Wide-field contact fundus photograph of an infant: 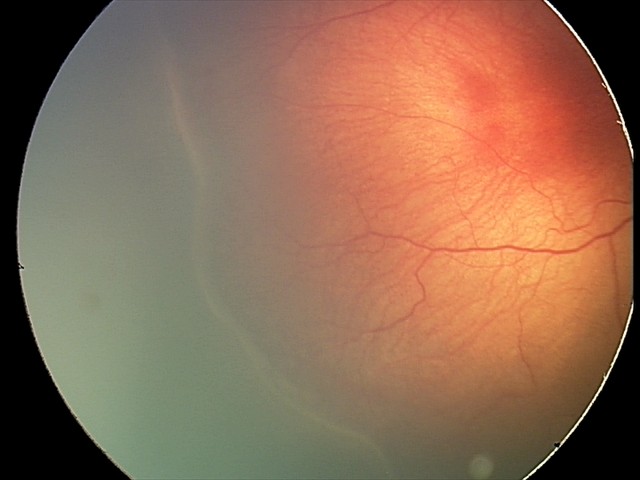
Q: Is plus disease present?
A: no plus disease
Q: What is the screening diagnosis?
A: ROP stage 2